Nonmydriatic: 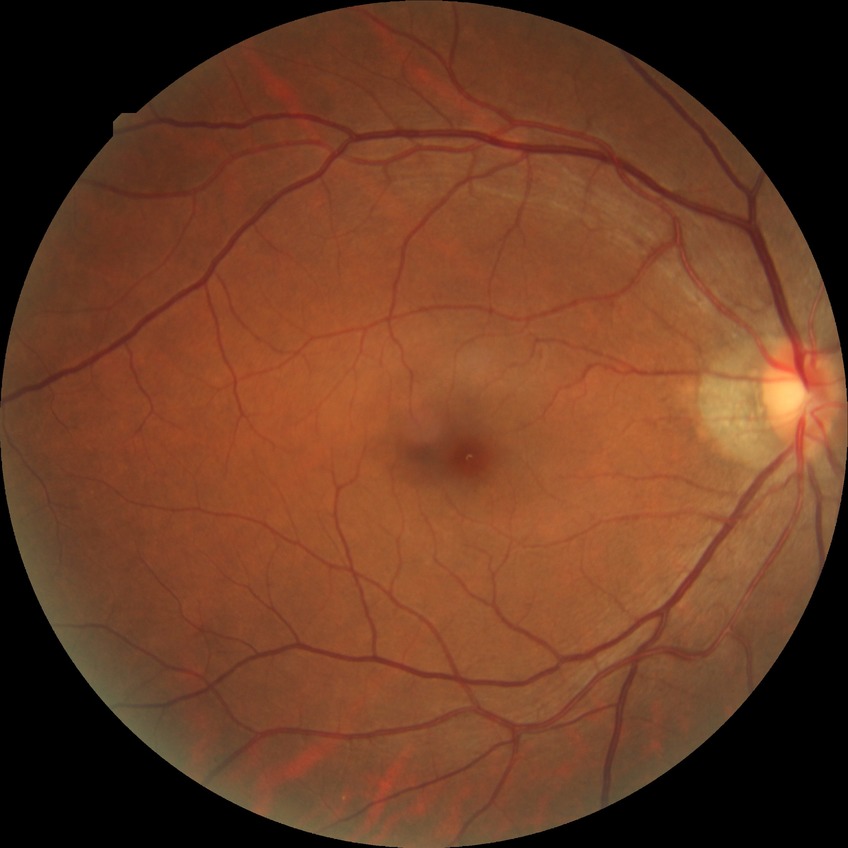 {
  "davis_grade": "no diabetic retinopathy"
}